Retinal fundus photograph, 2352x1568, 45-degree field of view — 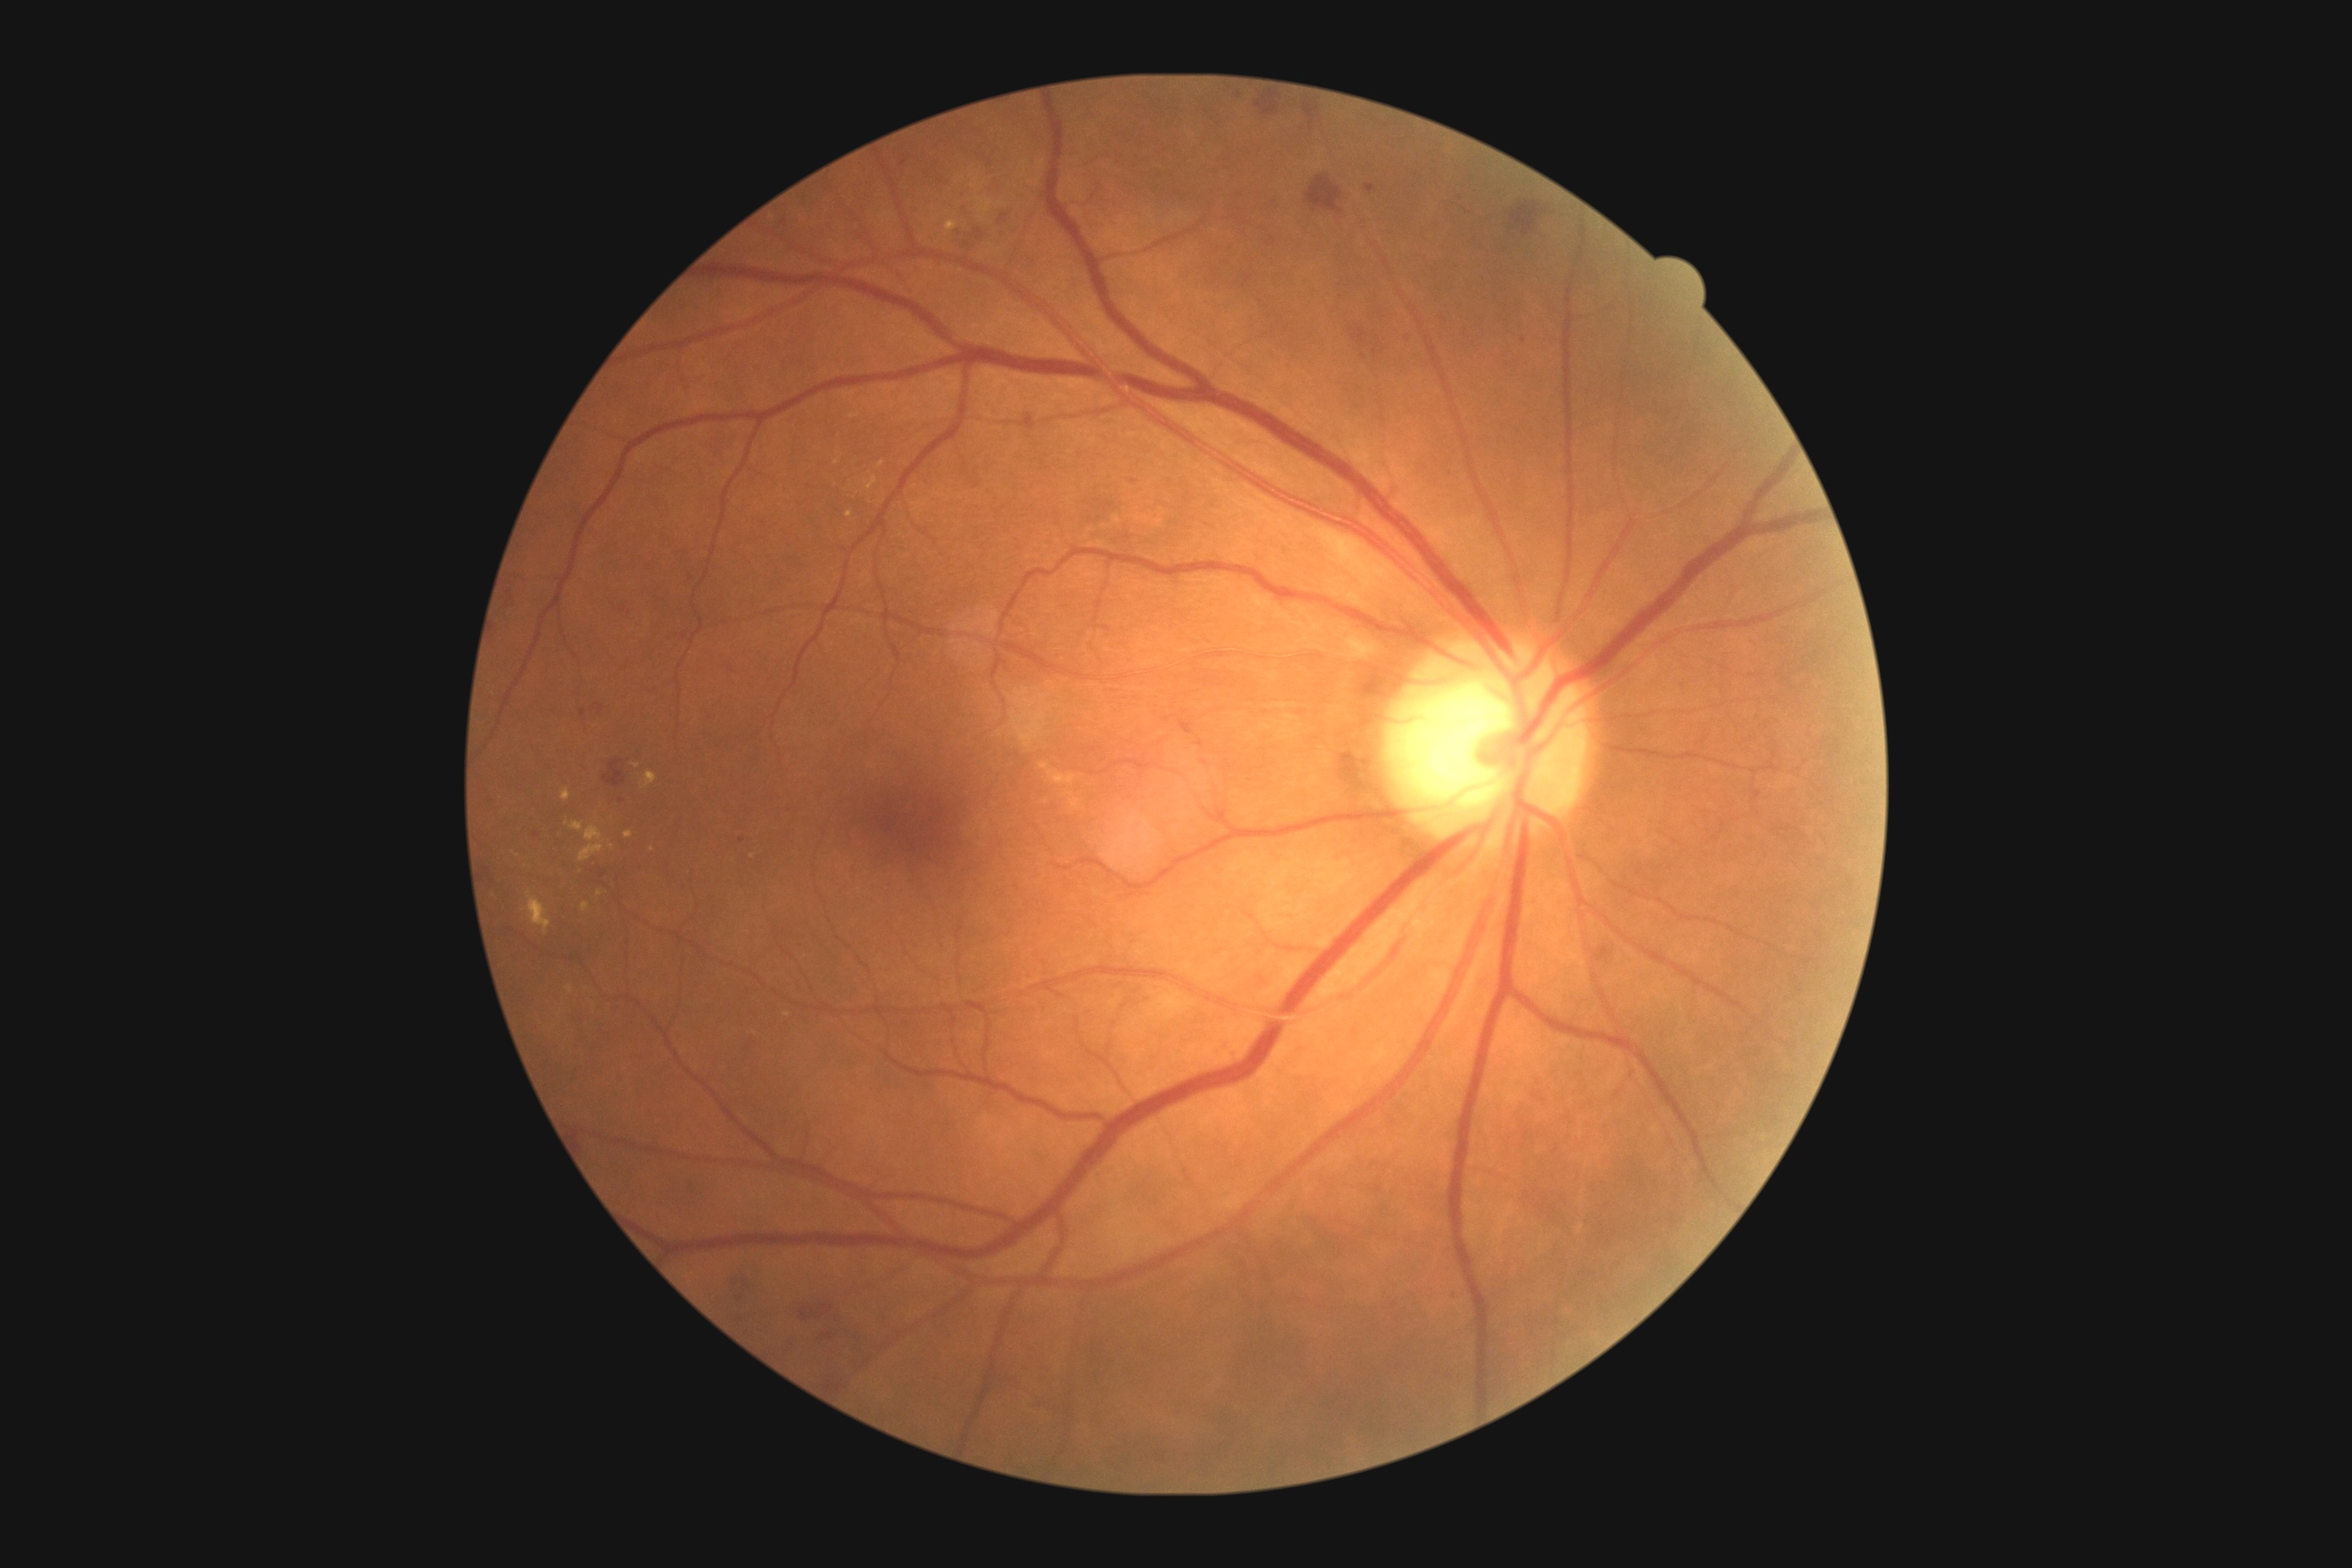

Diabetic retinopathy (DR): grade 2 (moderate NPDR)
Selected lesions:
hard exudates (EXs) (partial): <bbox>580, 845, 605, 861</bbox>, <bbox>642, 770, 658, 790</bbox>, <bbox>582, 903, 589, 914</bbox>, <bbox>562, 790, 571, 801</bbox>, <bbox>946, 220, 959, 233</bbox>
Additional small EXs near {"x": 516, "y": 855}, {"x": 837, "y": 463}, {"x": 652, "y": 850}, {"x": 611, "y": 847}, {"x": 787, "y": 1015}, {"x": 599, "y": 893}
hemorrhages (HEs) (partial): <bbox>594, 705, 605, 710</bbox>, <bbox>740, 1037, 754, 1055</bbox>, <bbox>571, 1004, 587, 1024</bbox>, <bbox>1509, 202, 1547, 237</bbox>, <bbox>685, 573, 696, 585</bbox>, <bbox>720, 654, 738, 674</bbox>, <bbox>643, 948, 651, 963</bbox>, <bbox>779, 1340, 798, 1357</bbox>, <bbox>1366, 184, 1377, 193</bbox>, <bbox>912, 266, 919, 275</bbox>, <bbox>1181, 720, 1193, 736</bbox>, <bbox>1346, 322, 1387, 362</bbox>, <bbox>816, 1371, 848, 1395</bbox>
Additional small HEs near {"x": 741, "y": 840}, {"x": 903, "y": 163}, {"x": 622, "y": 801}